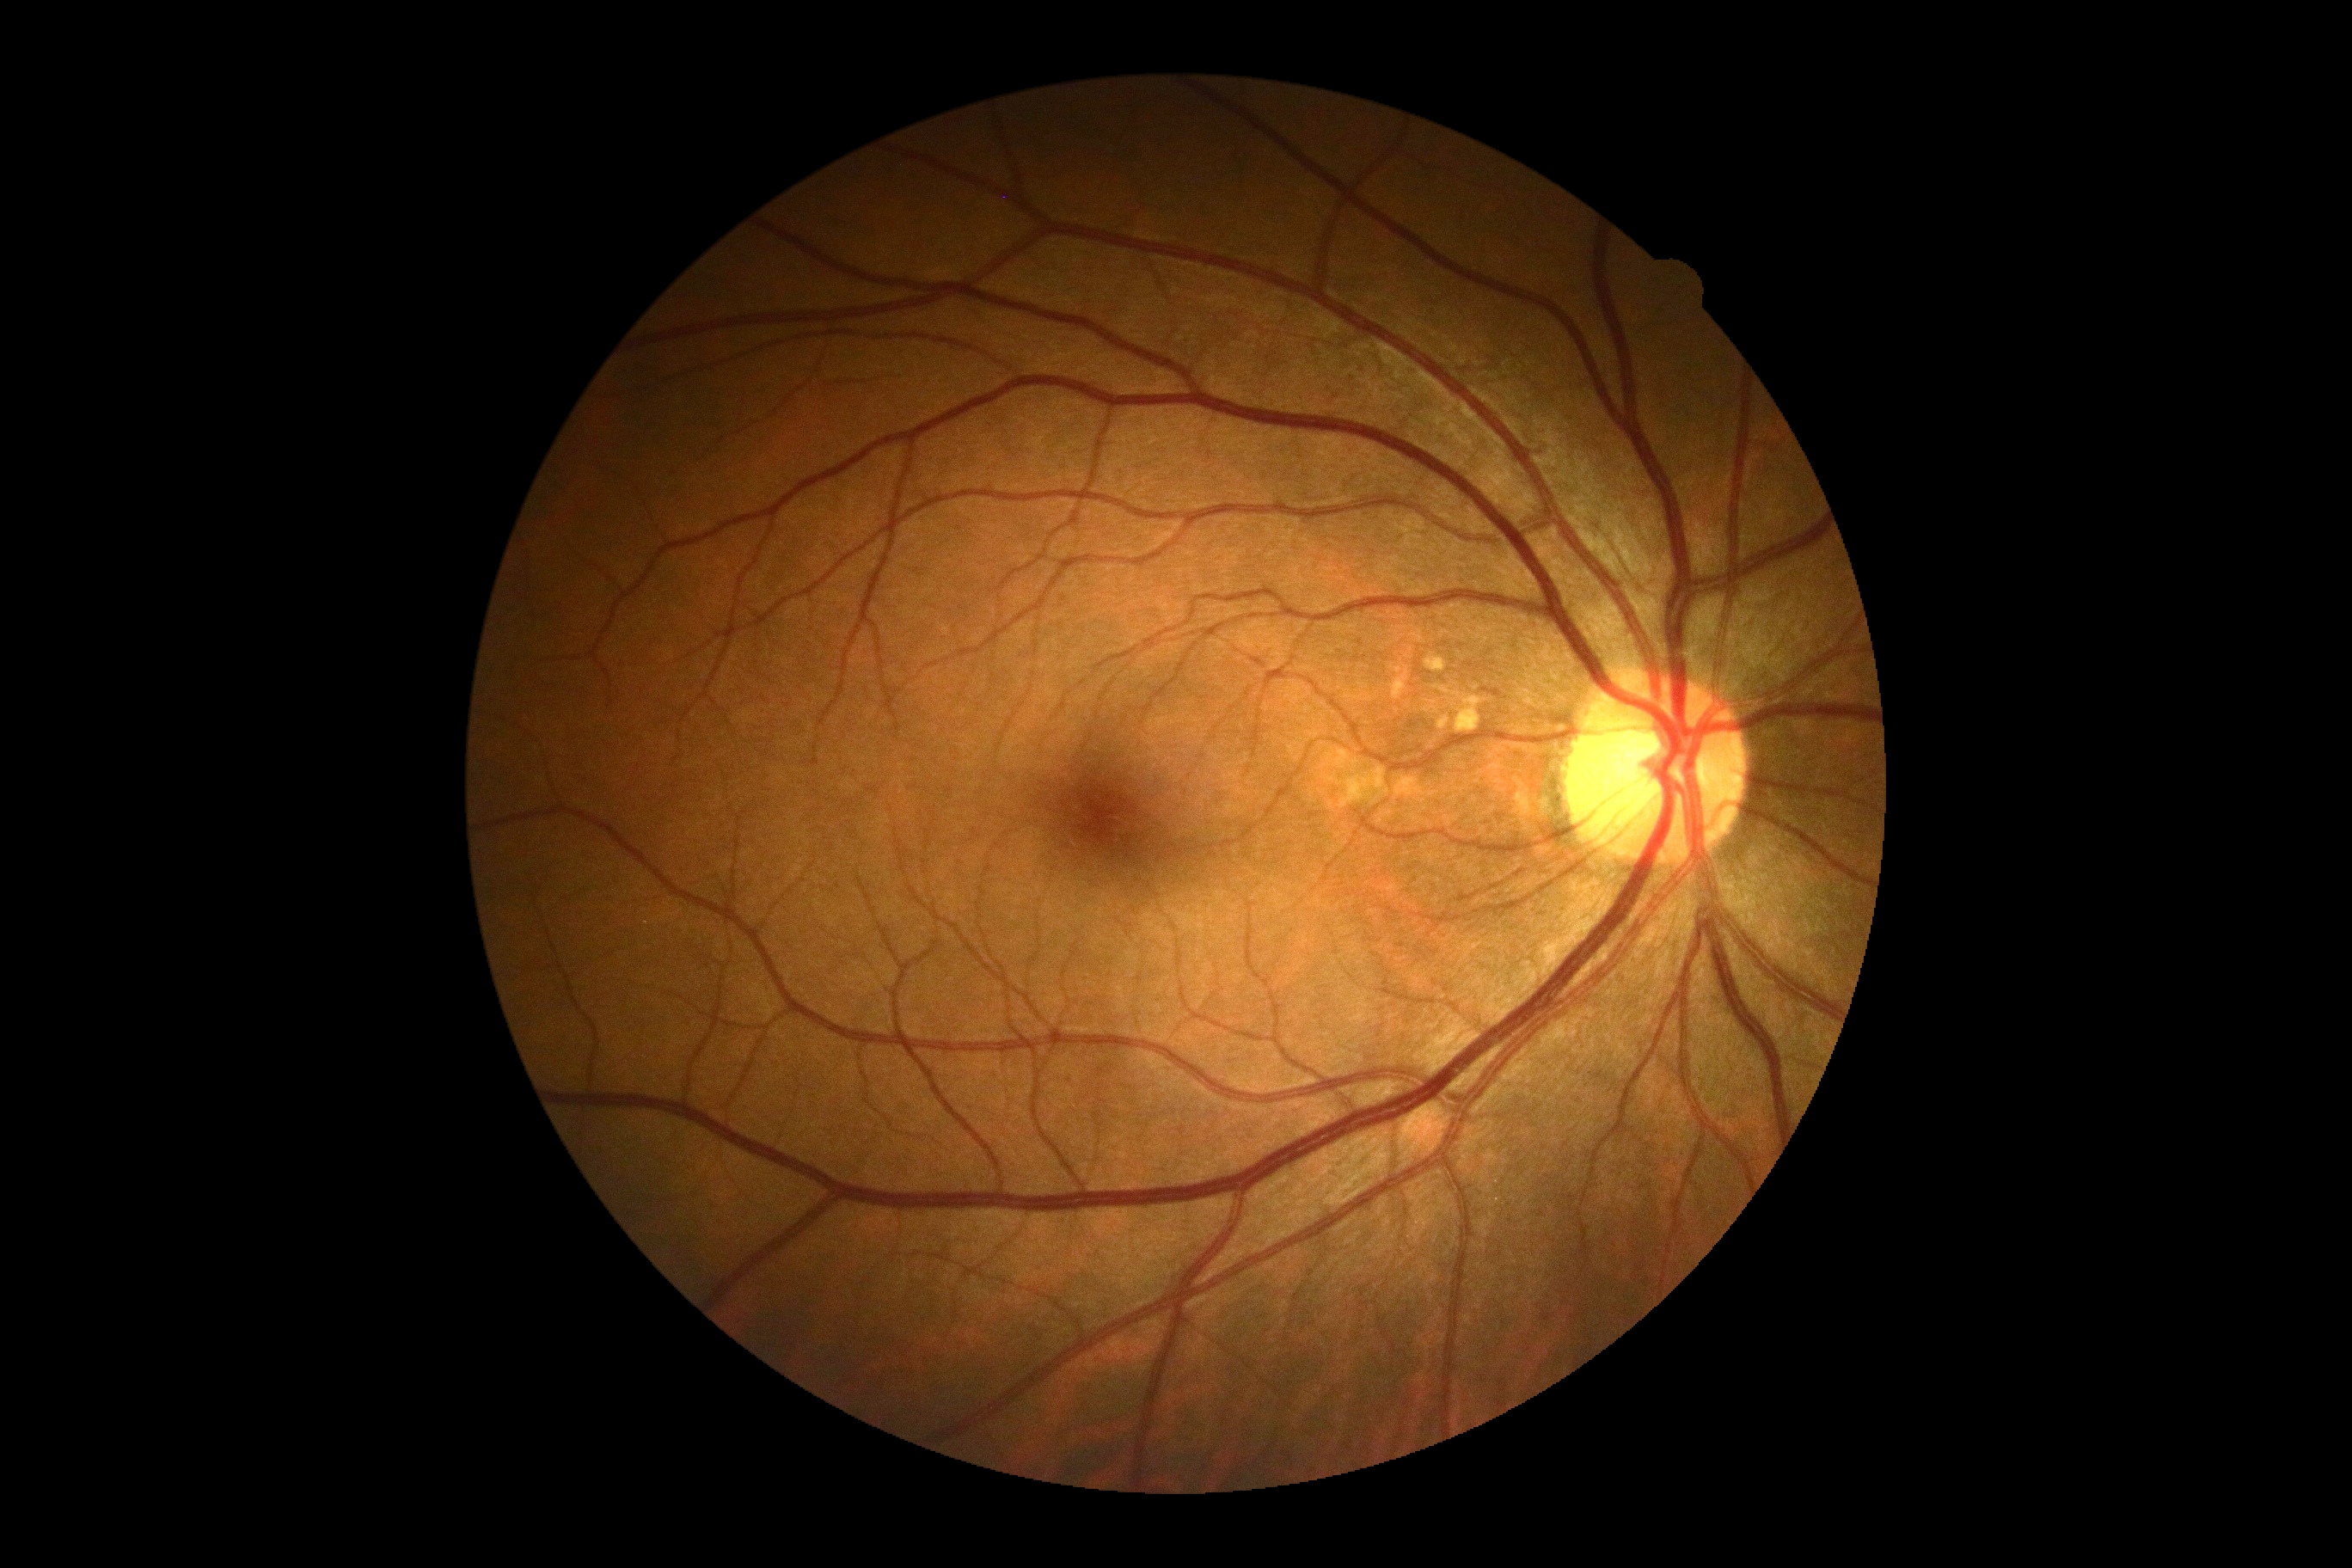 No diabetic retinal disease findings. Diabetic retinopathy (DR) is grade 0.